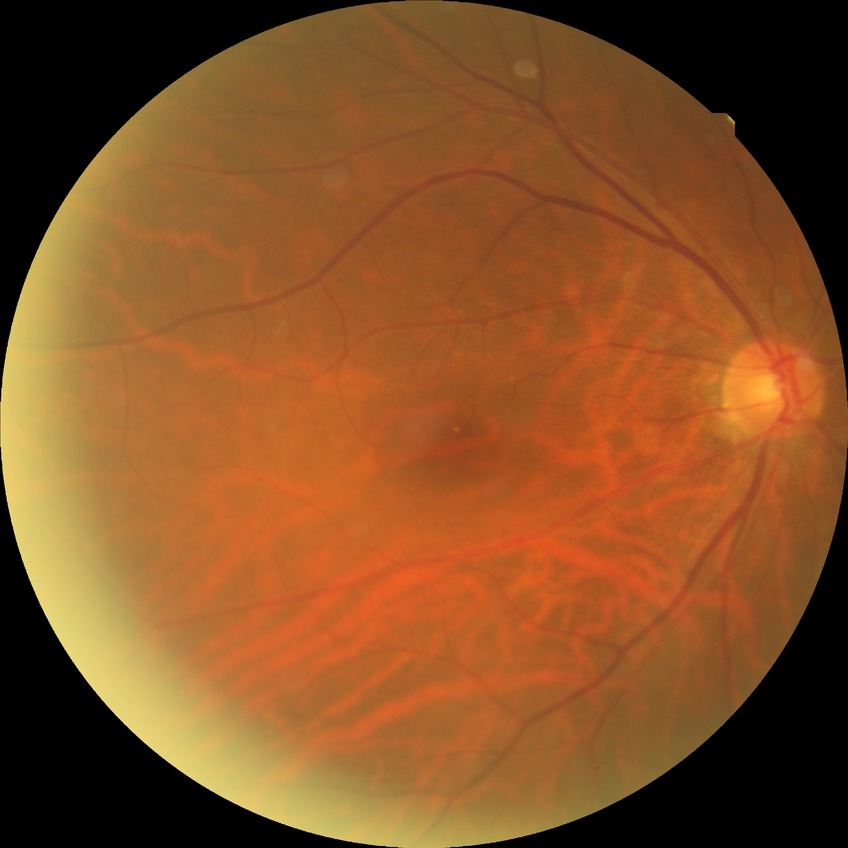

Diabetic retinopathy (DR): NDR (no diabetic retinopathy).